45° field of view:
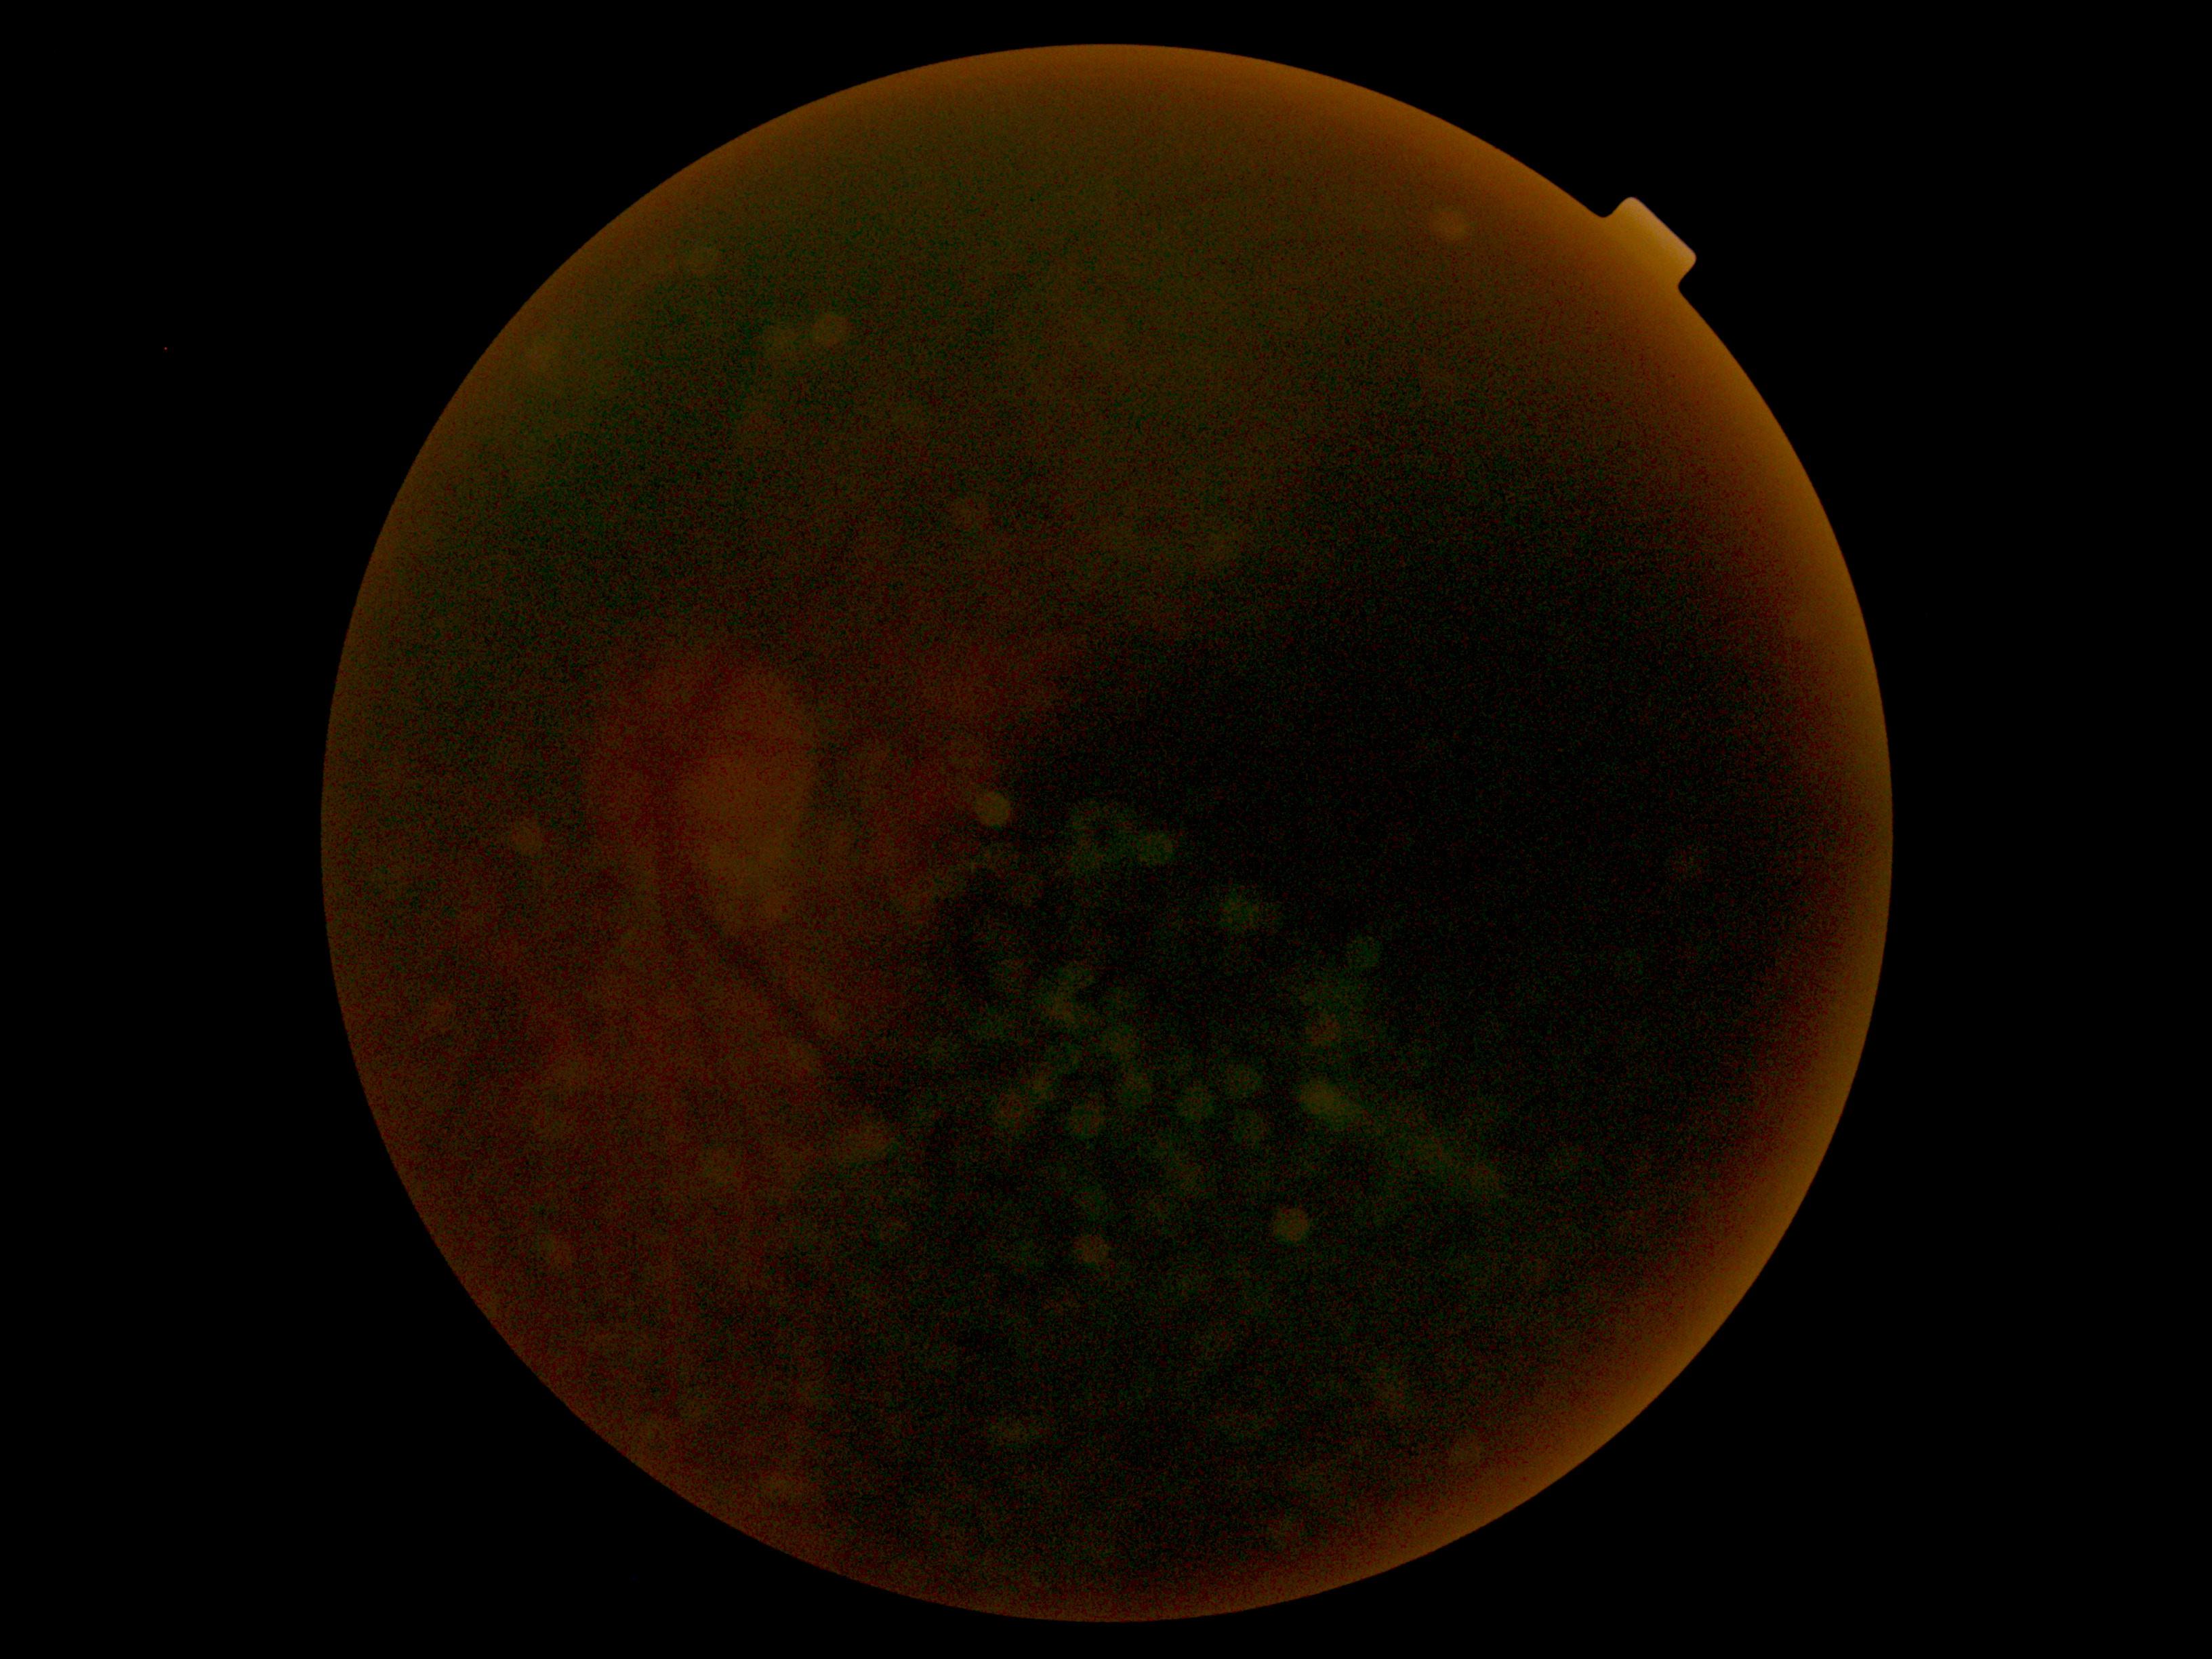
Diabetic retinopathy severity: ungradable due to poor image quality.